Graded on the modified Davis scale, retinal fundus photograph, 848x848px — 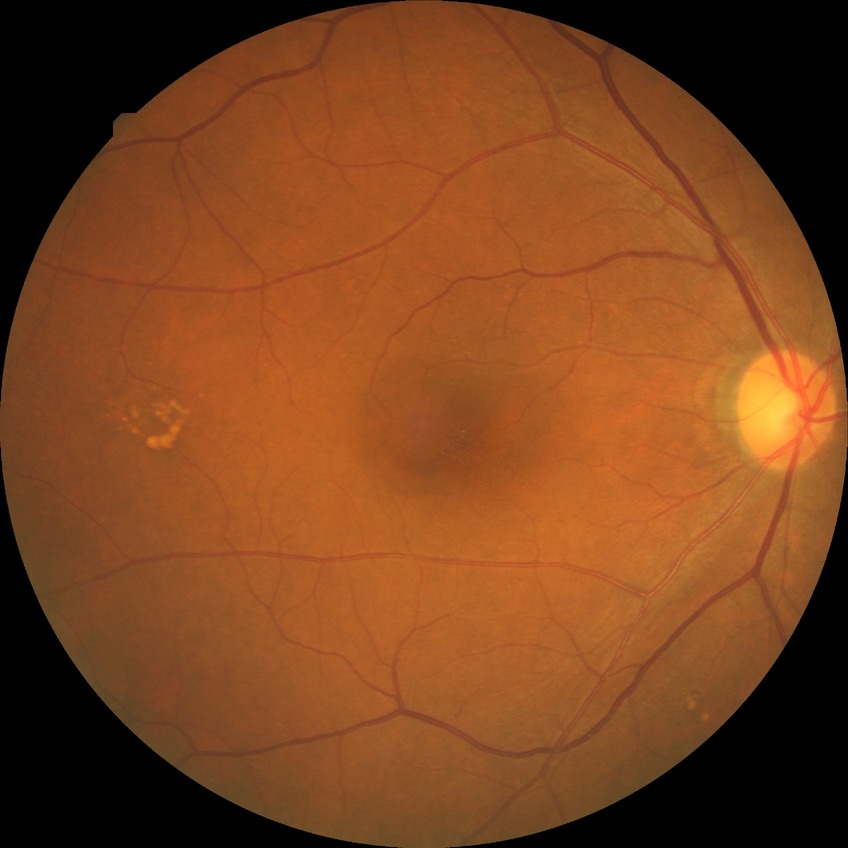
davis_grade: no diabetic retinopathy